Davis DR grading, 45° field of view — 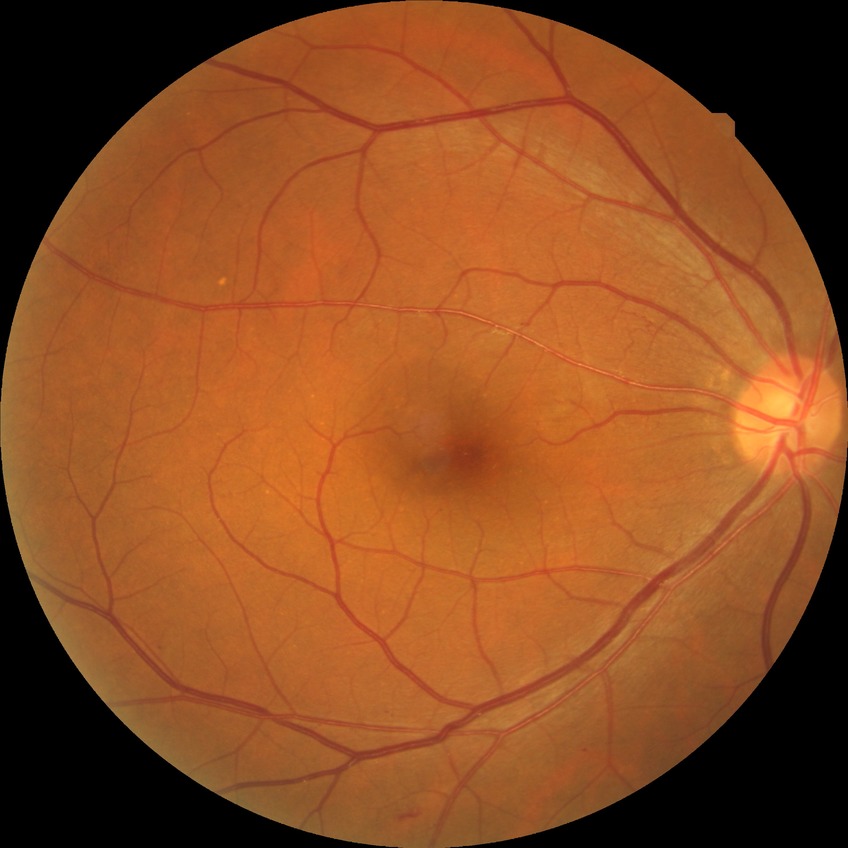 Diabetic retinopathy severity is no diabetic retinopathy.